Wide-field contact fundus photograph of an infant · 1240 x 1240 pixels · camera: Phoenix ICON (100° FOV).
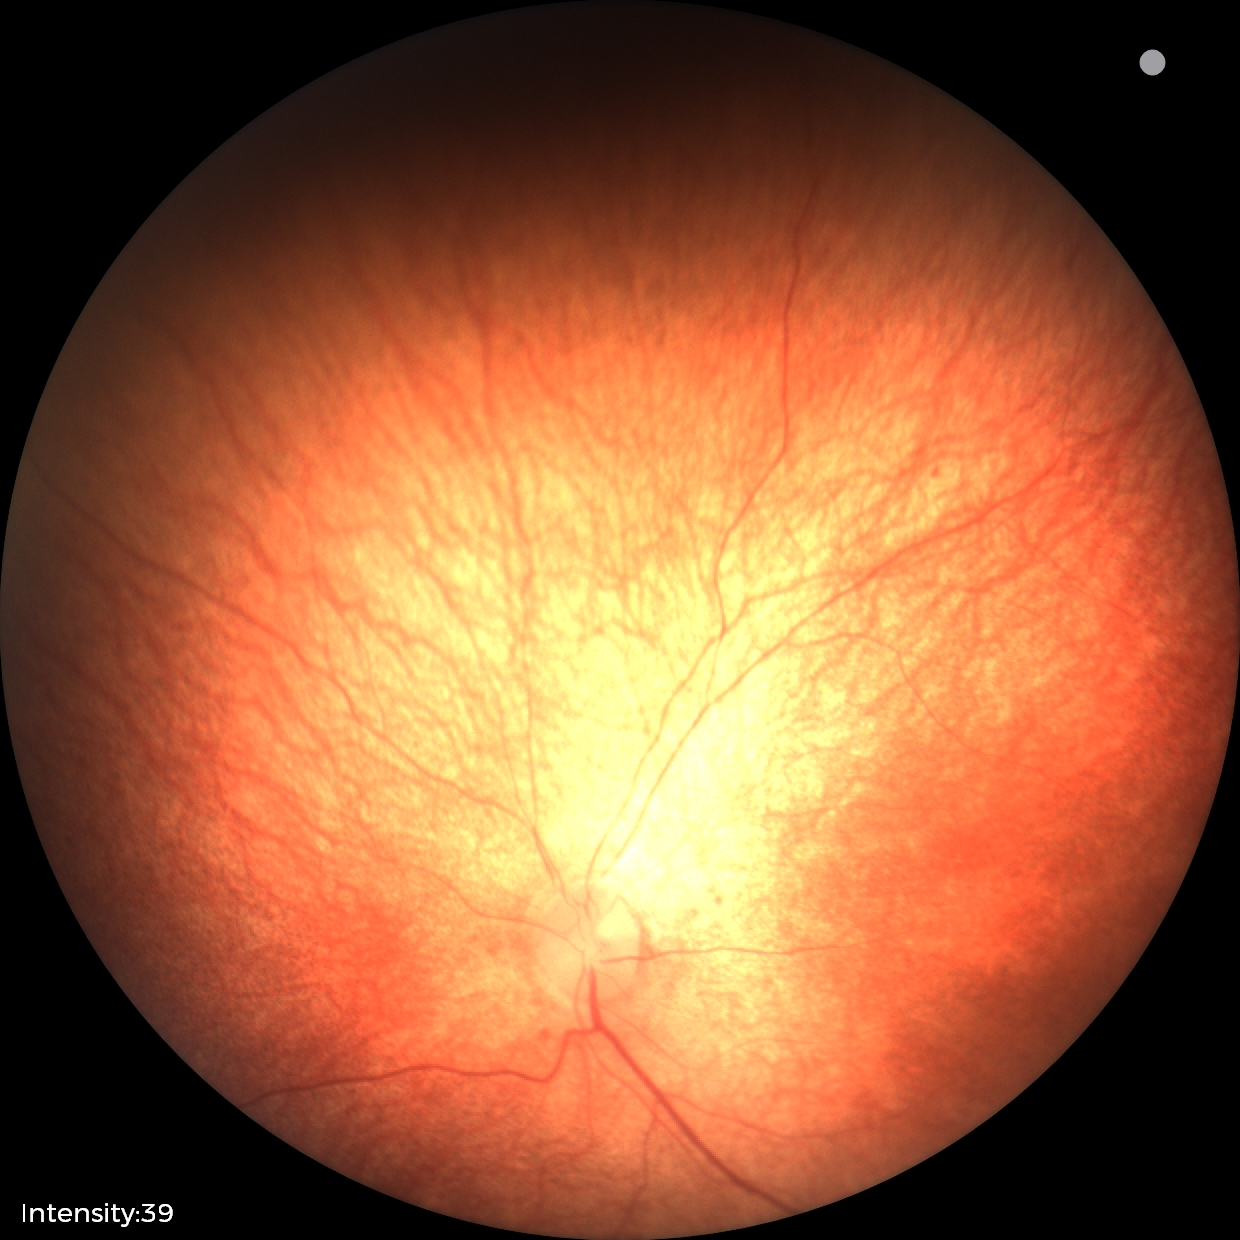

Screening examination with no abnormal retinal findings.